Acquired on the Clarity RetCam 3; wide-field fundus image from infant ROP screening
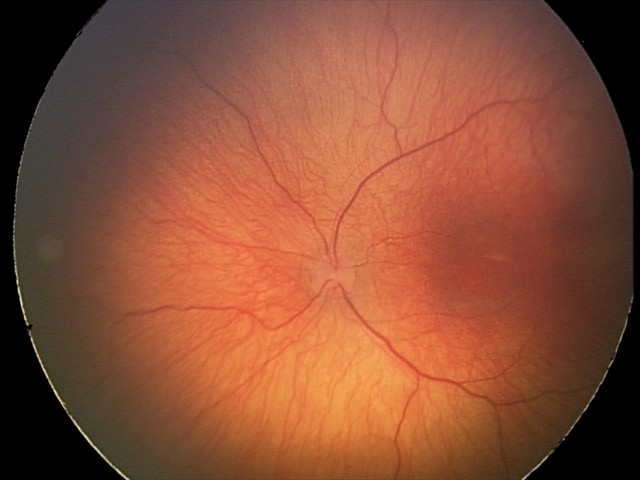 Diagnosis from this screening exam: status post ROP.